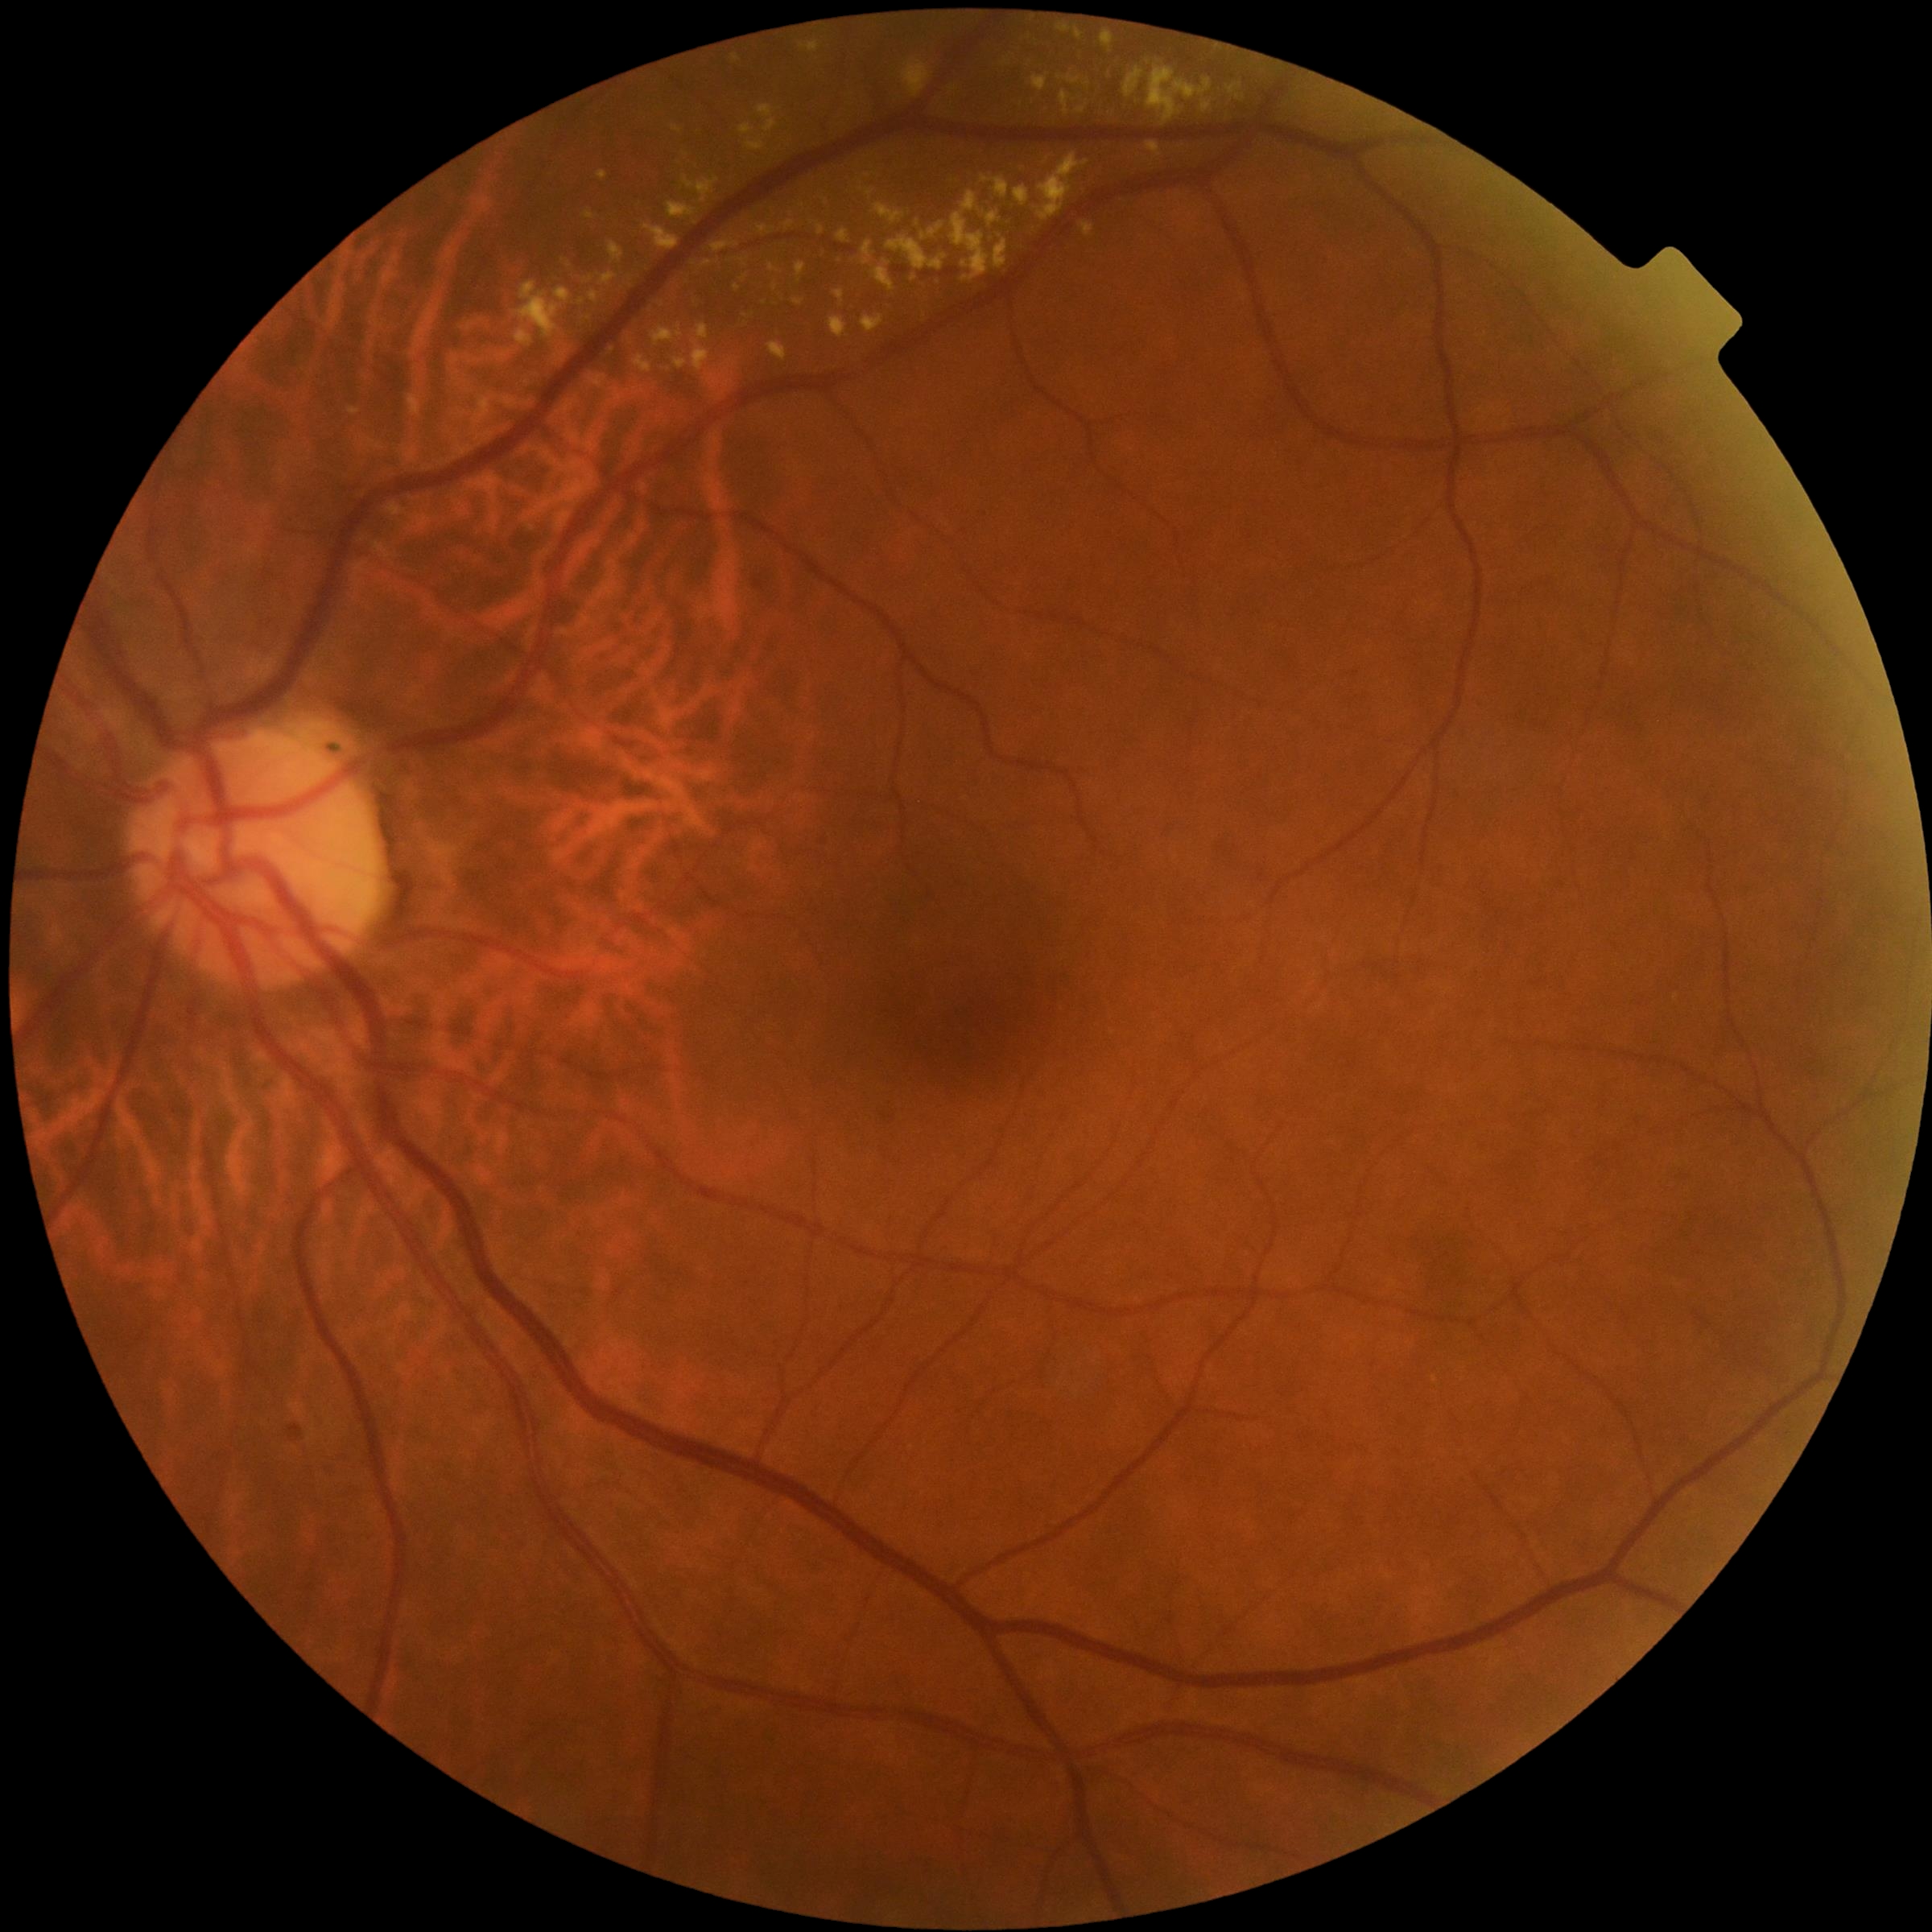
DR severity: 2/4
Representative lesions:
- EXs (continued): Rect(693, 324, 712, 374), Rect(1033, 154, 1089, 223), Rect(758, 225, 775, 236), Rect(724, 381, 733, 388), Rect(1057, 75, 1082, 86), Rect(738, 258, 747, 266), Rect(651, 326, 683, 345), Rect(388, 503, 407, 516), Rect(349, 409, 360, 416), Rect(1084, 223, 1095, 238), Rect(368, 441, 382, 450), Rect(741, 275, 749, 281), Rect(768, 343, 789, 362), Rect(1014, 188, 1031, 208)
- Small EXs near (569; 266), (1148; 63), (776; 288)